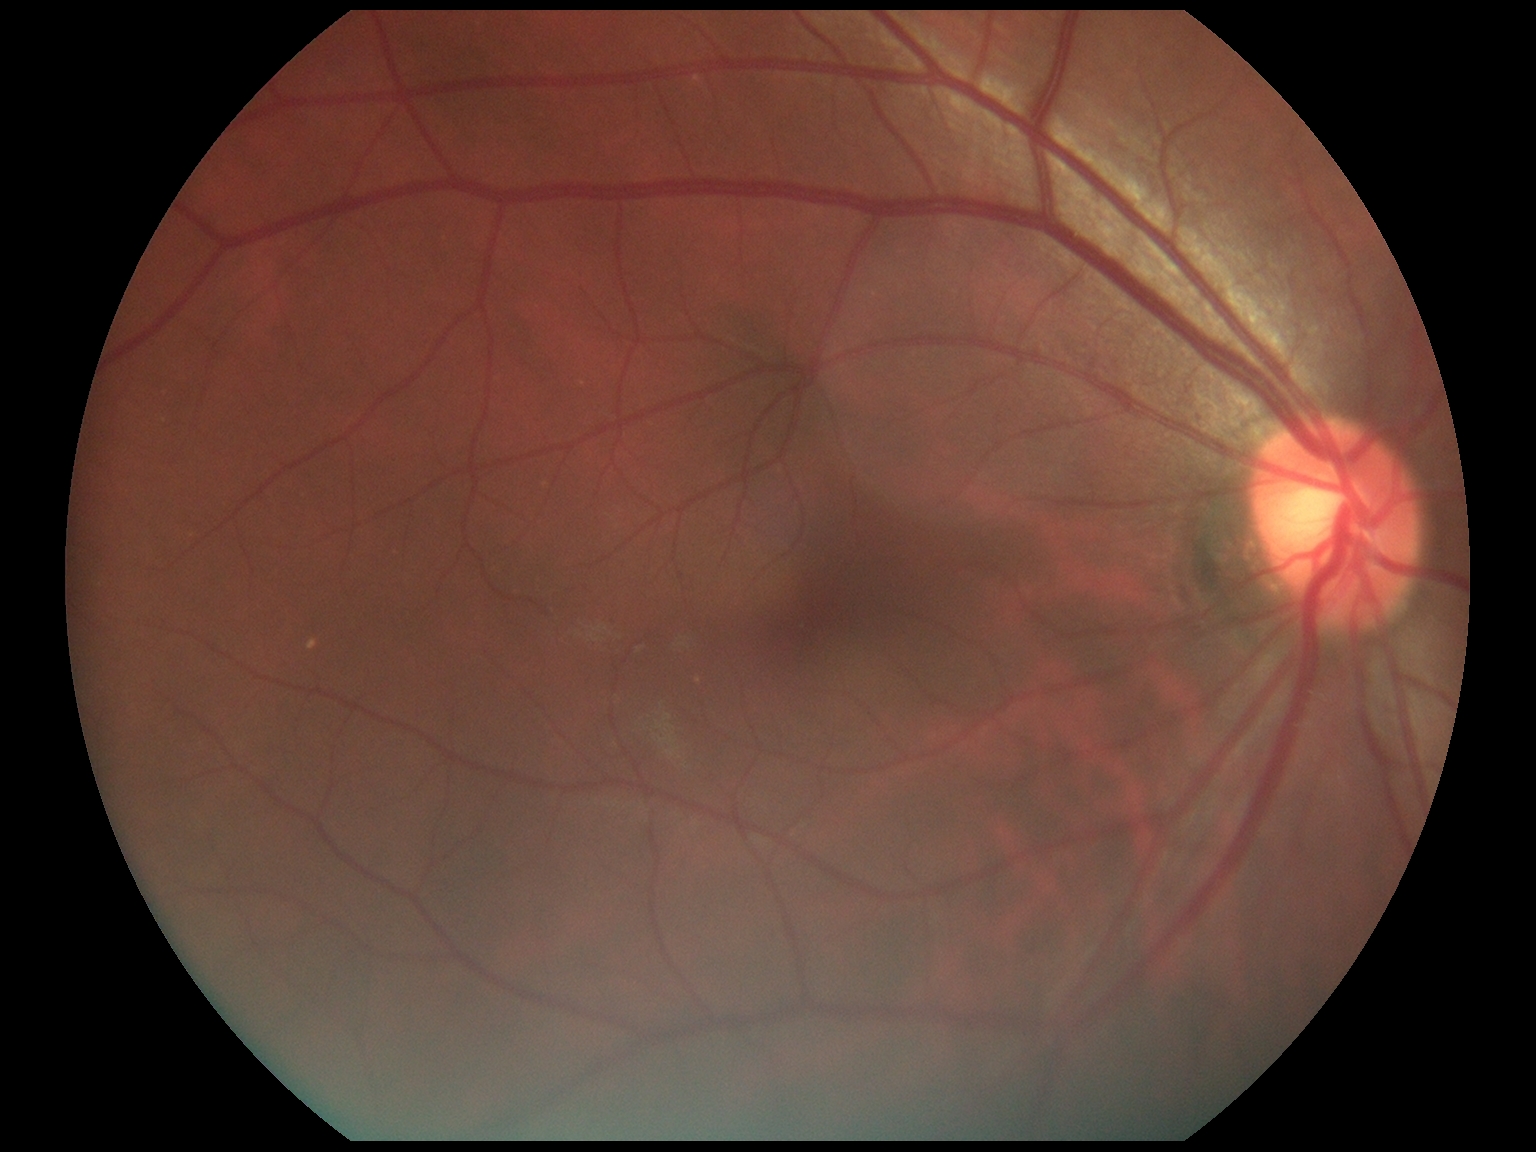

Diabetic retinopathy: no apparent retinopathy (grade 0).